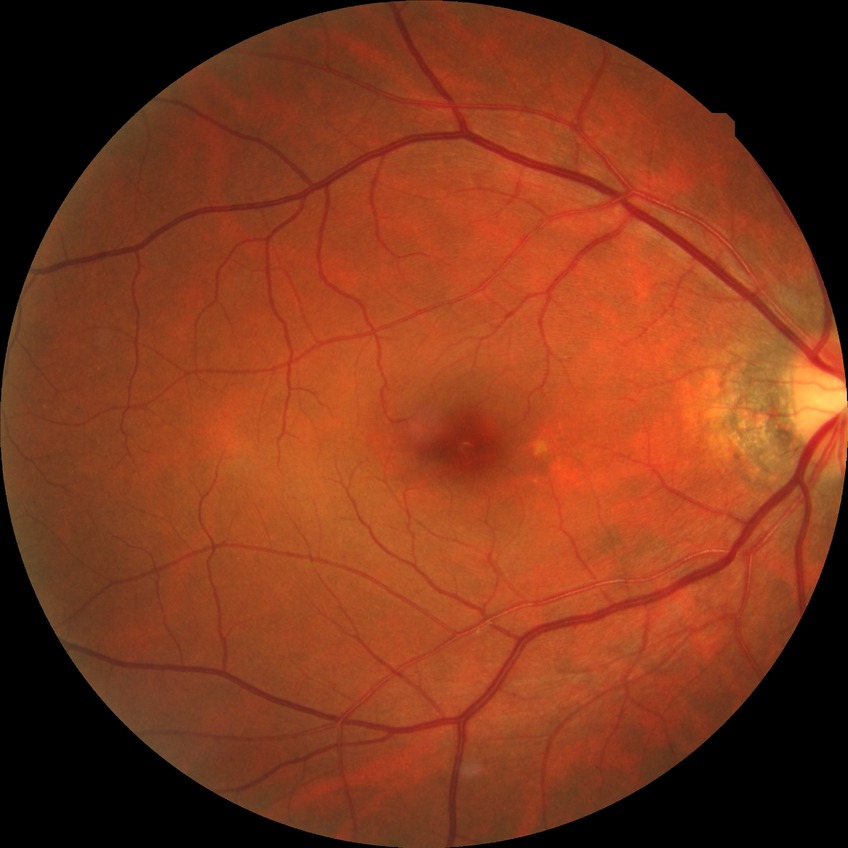
davis_grade: no diabetic retinopathy (NDR)